848x848px:
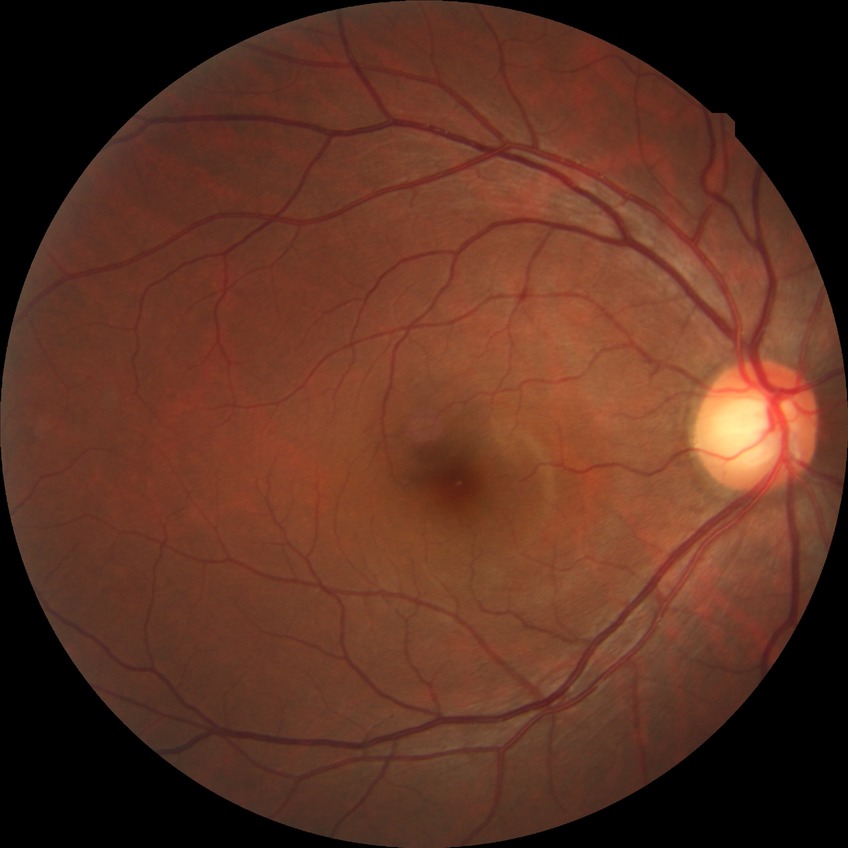 diabetic retinopathy (DR)=NDR (no diabetic retinopathy).